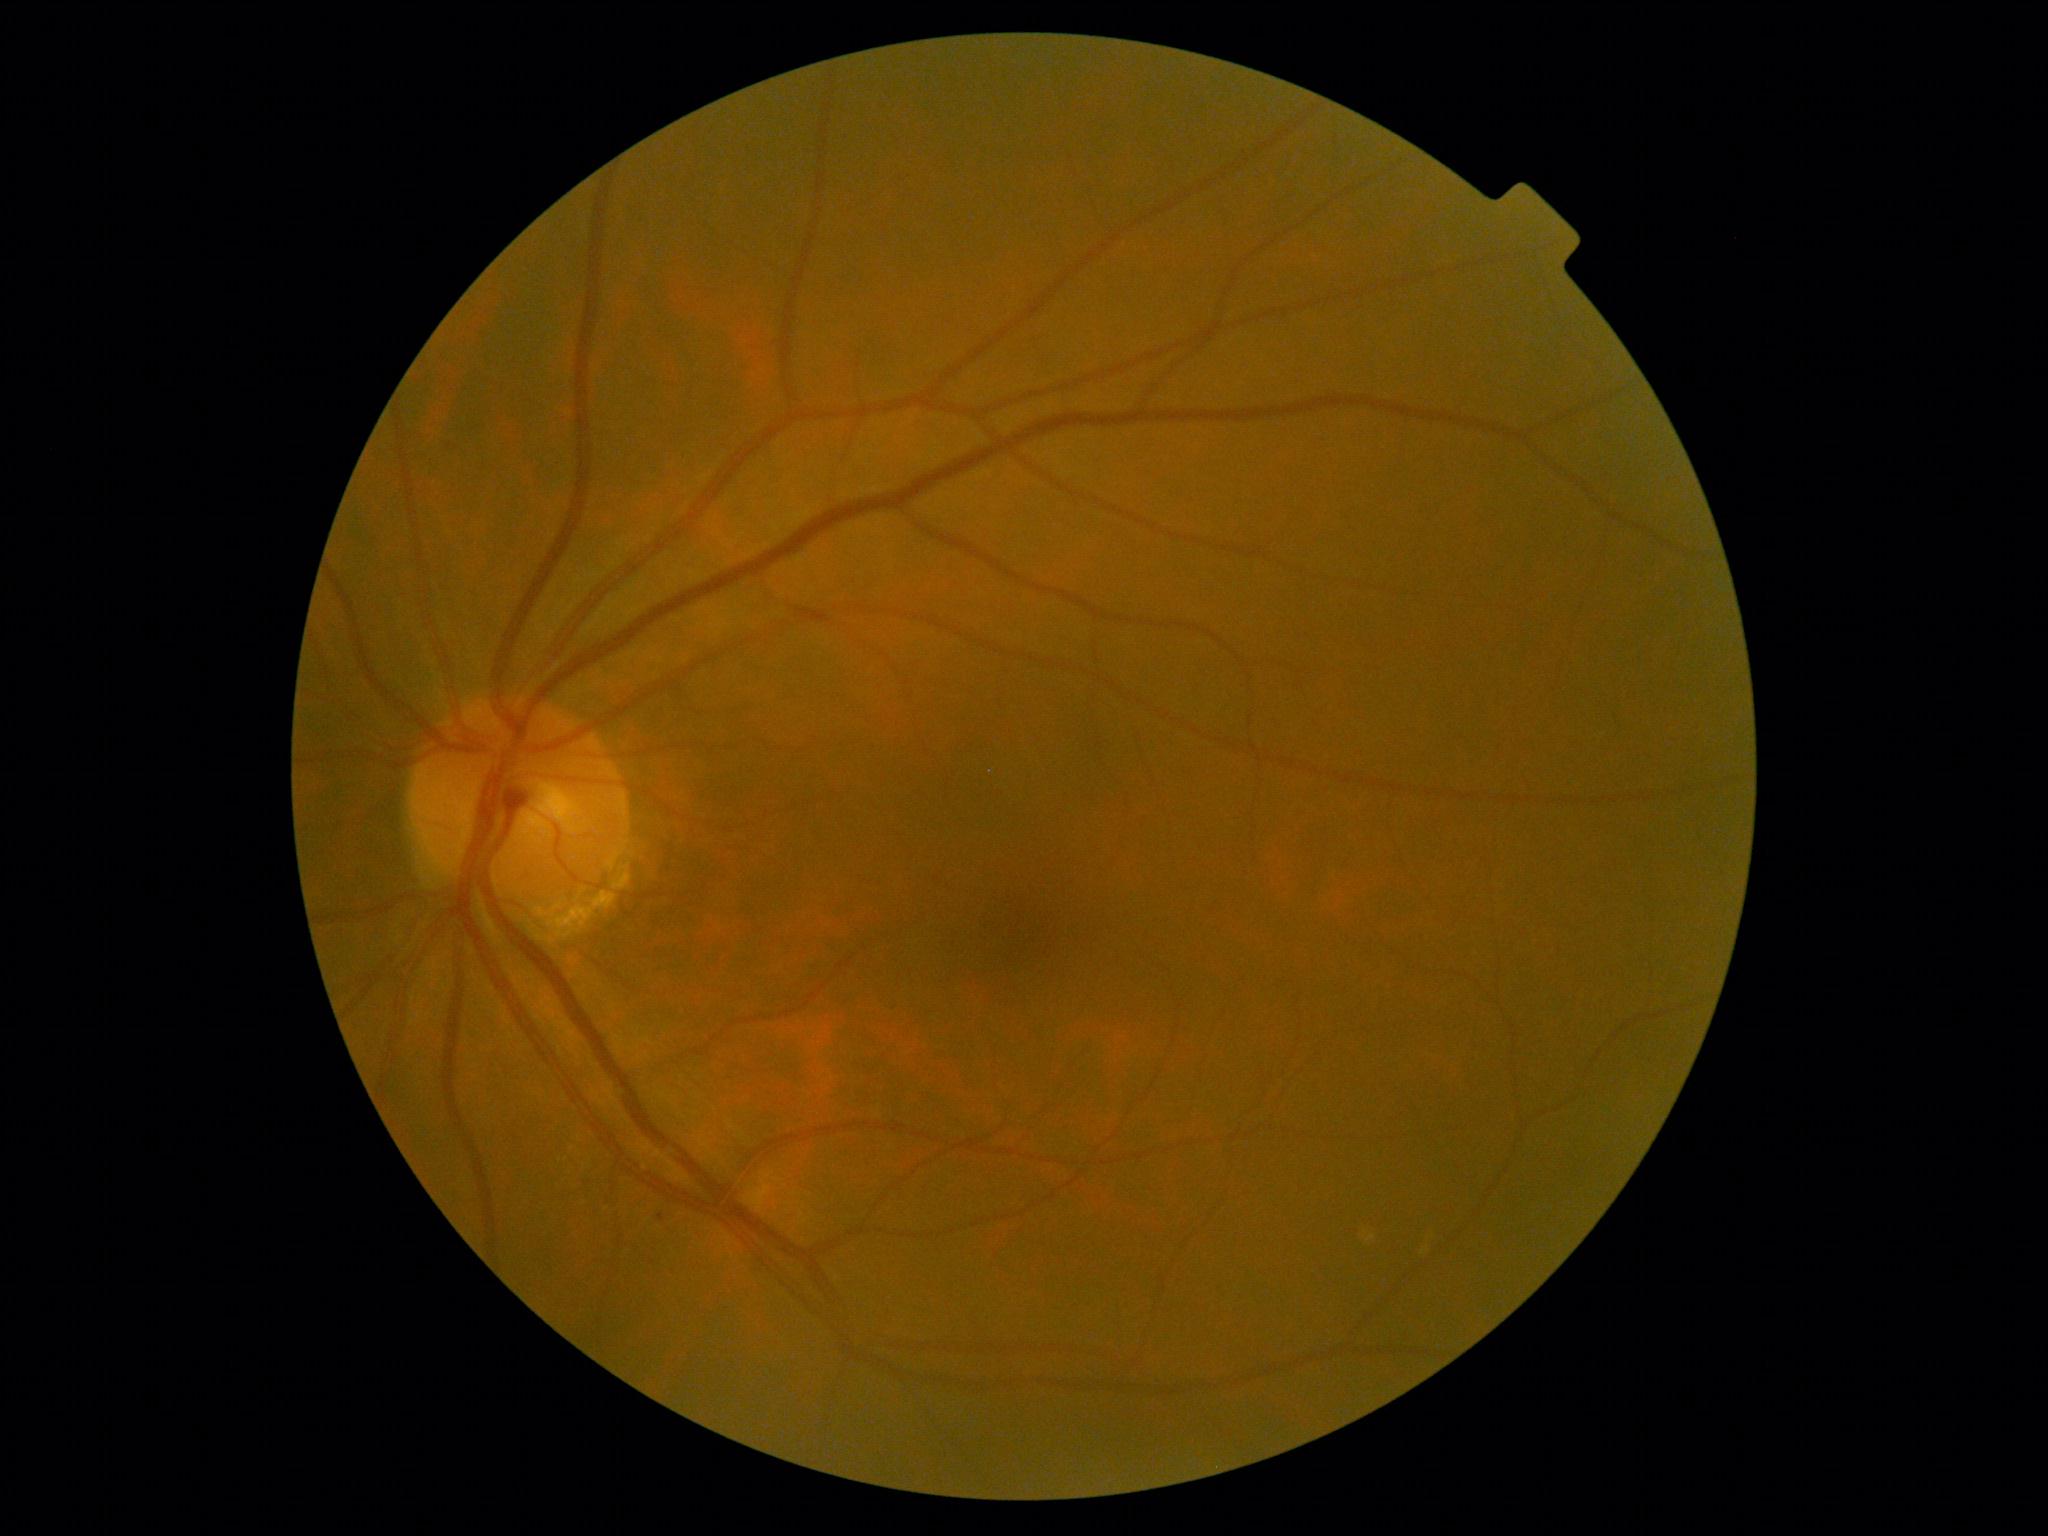

Findings:
* DR class — non-proliferative diabetic retinopathy
* DR grade — 1